2212 x 1659 pixels: 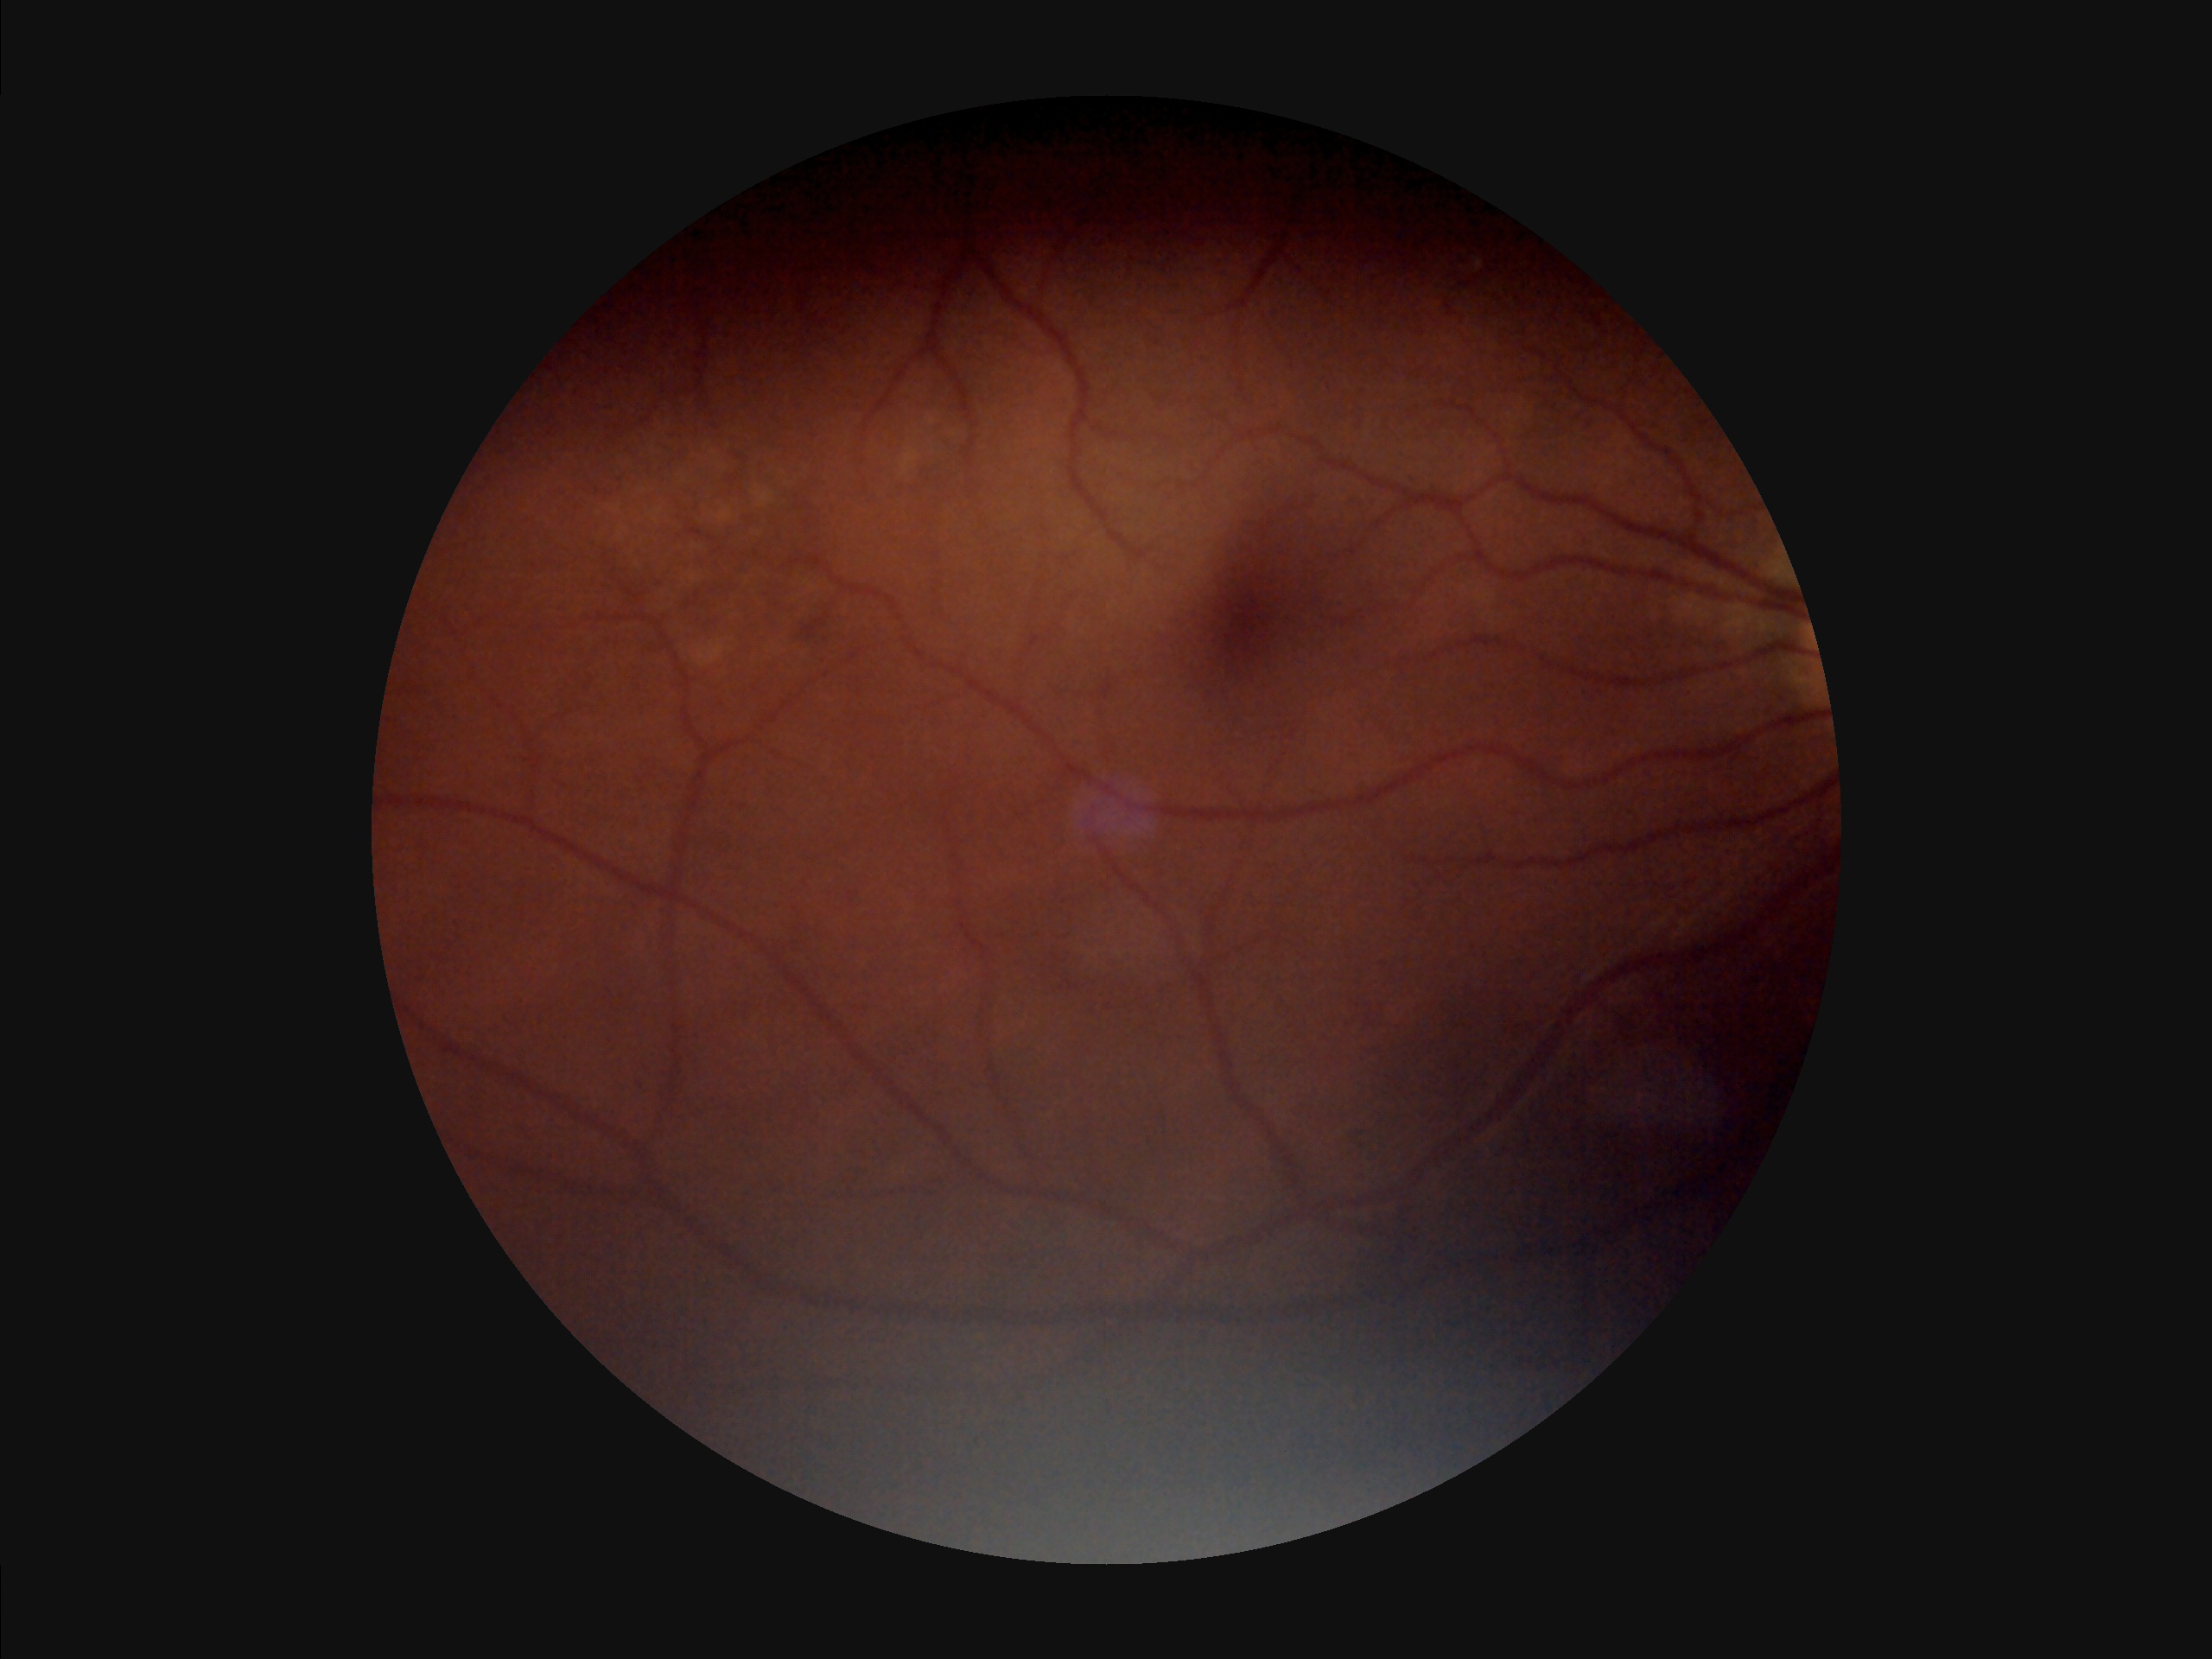
Overall image quality: low; Focus: poor; Illumination: poor; Contrast: reduced.